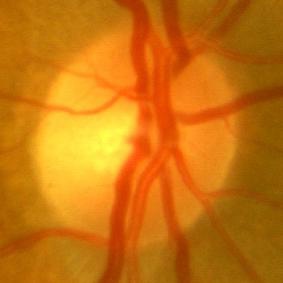 Finding = no glaucomatous damage.